2352 by 1568 pixels.
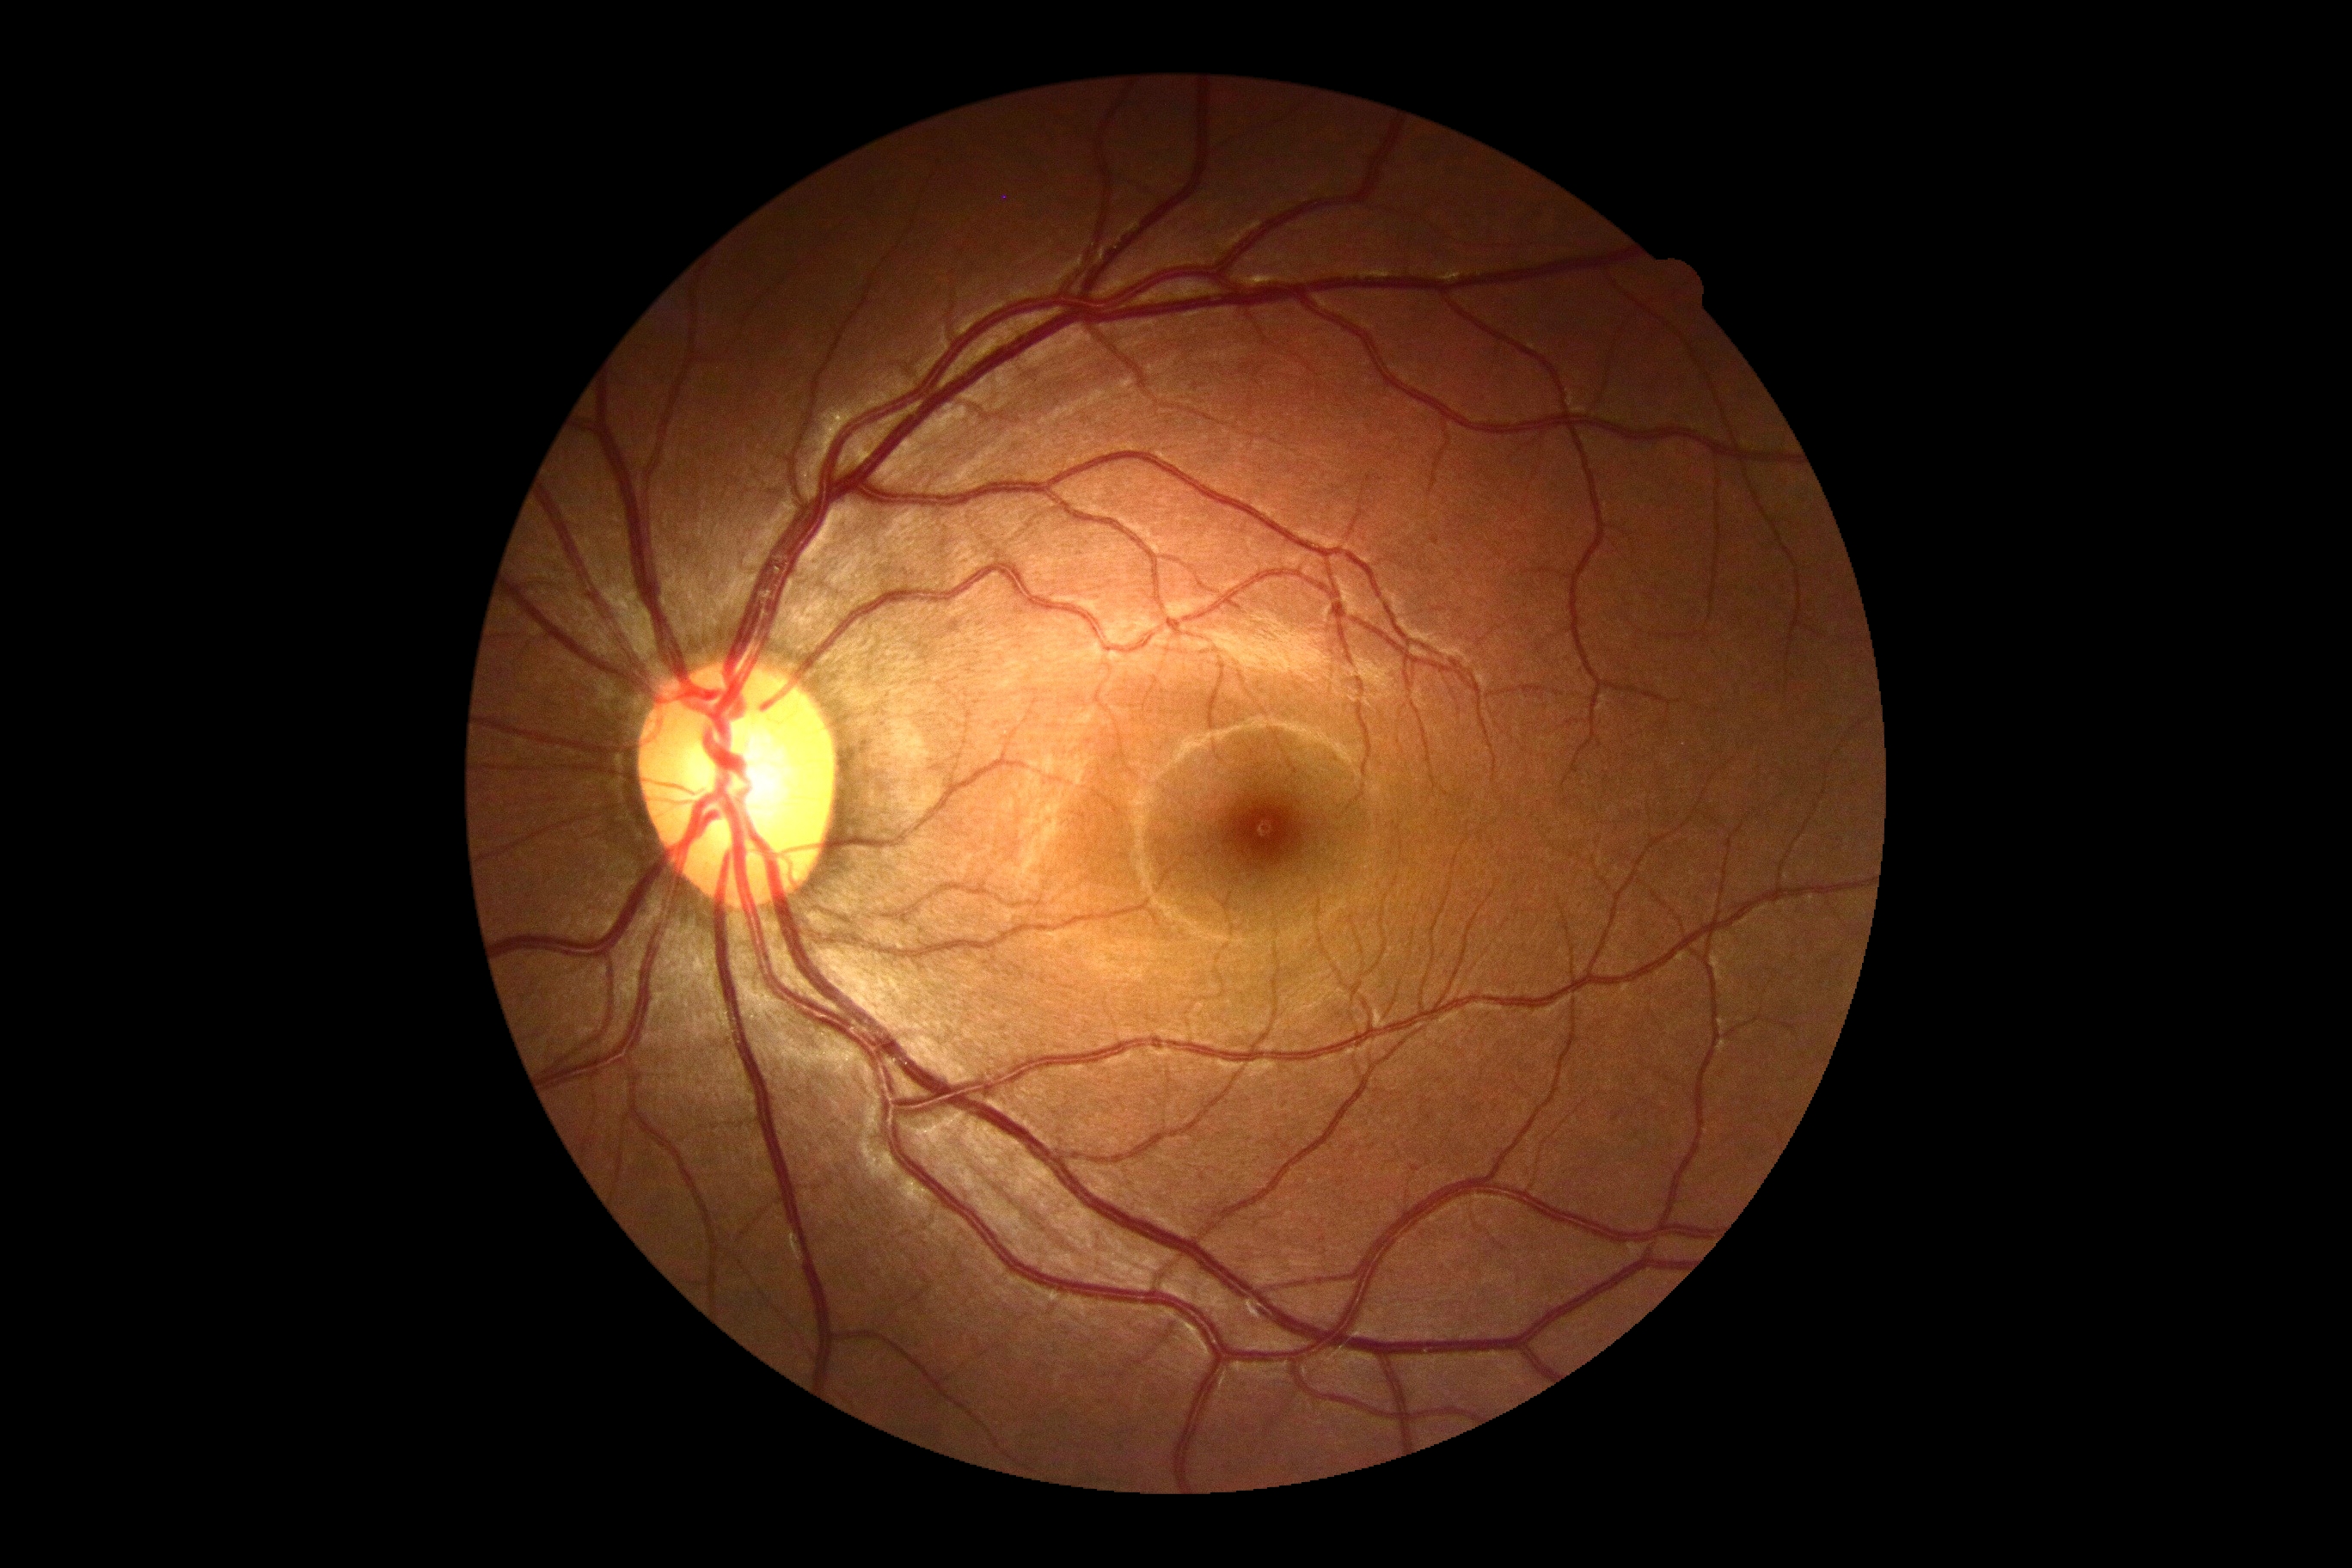 DR grade: 0 (no apparent retinopathy)